Acquired with a Remidio FOP fundus camera:
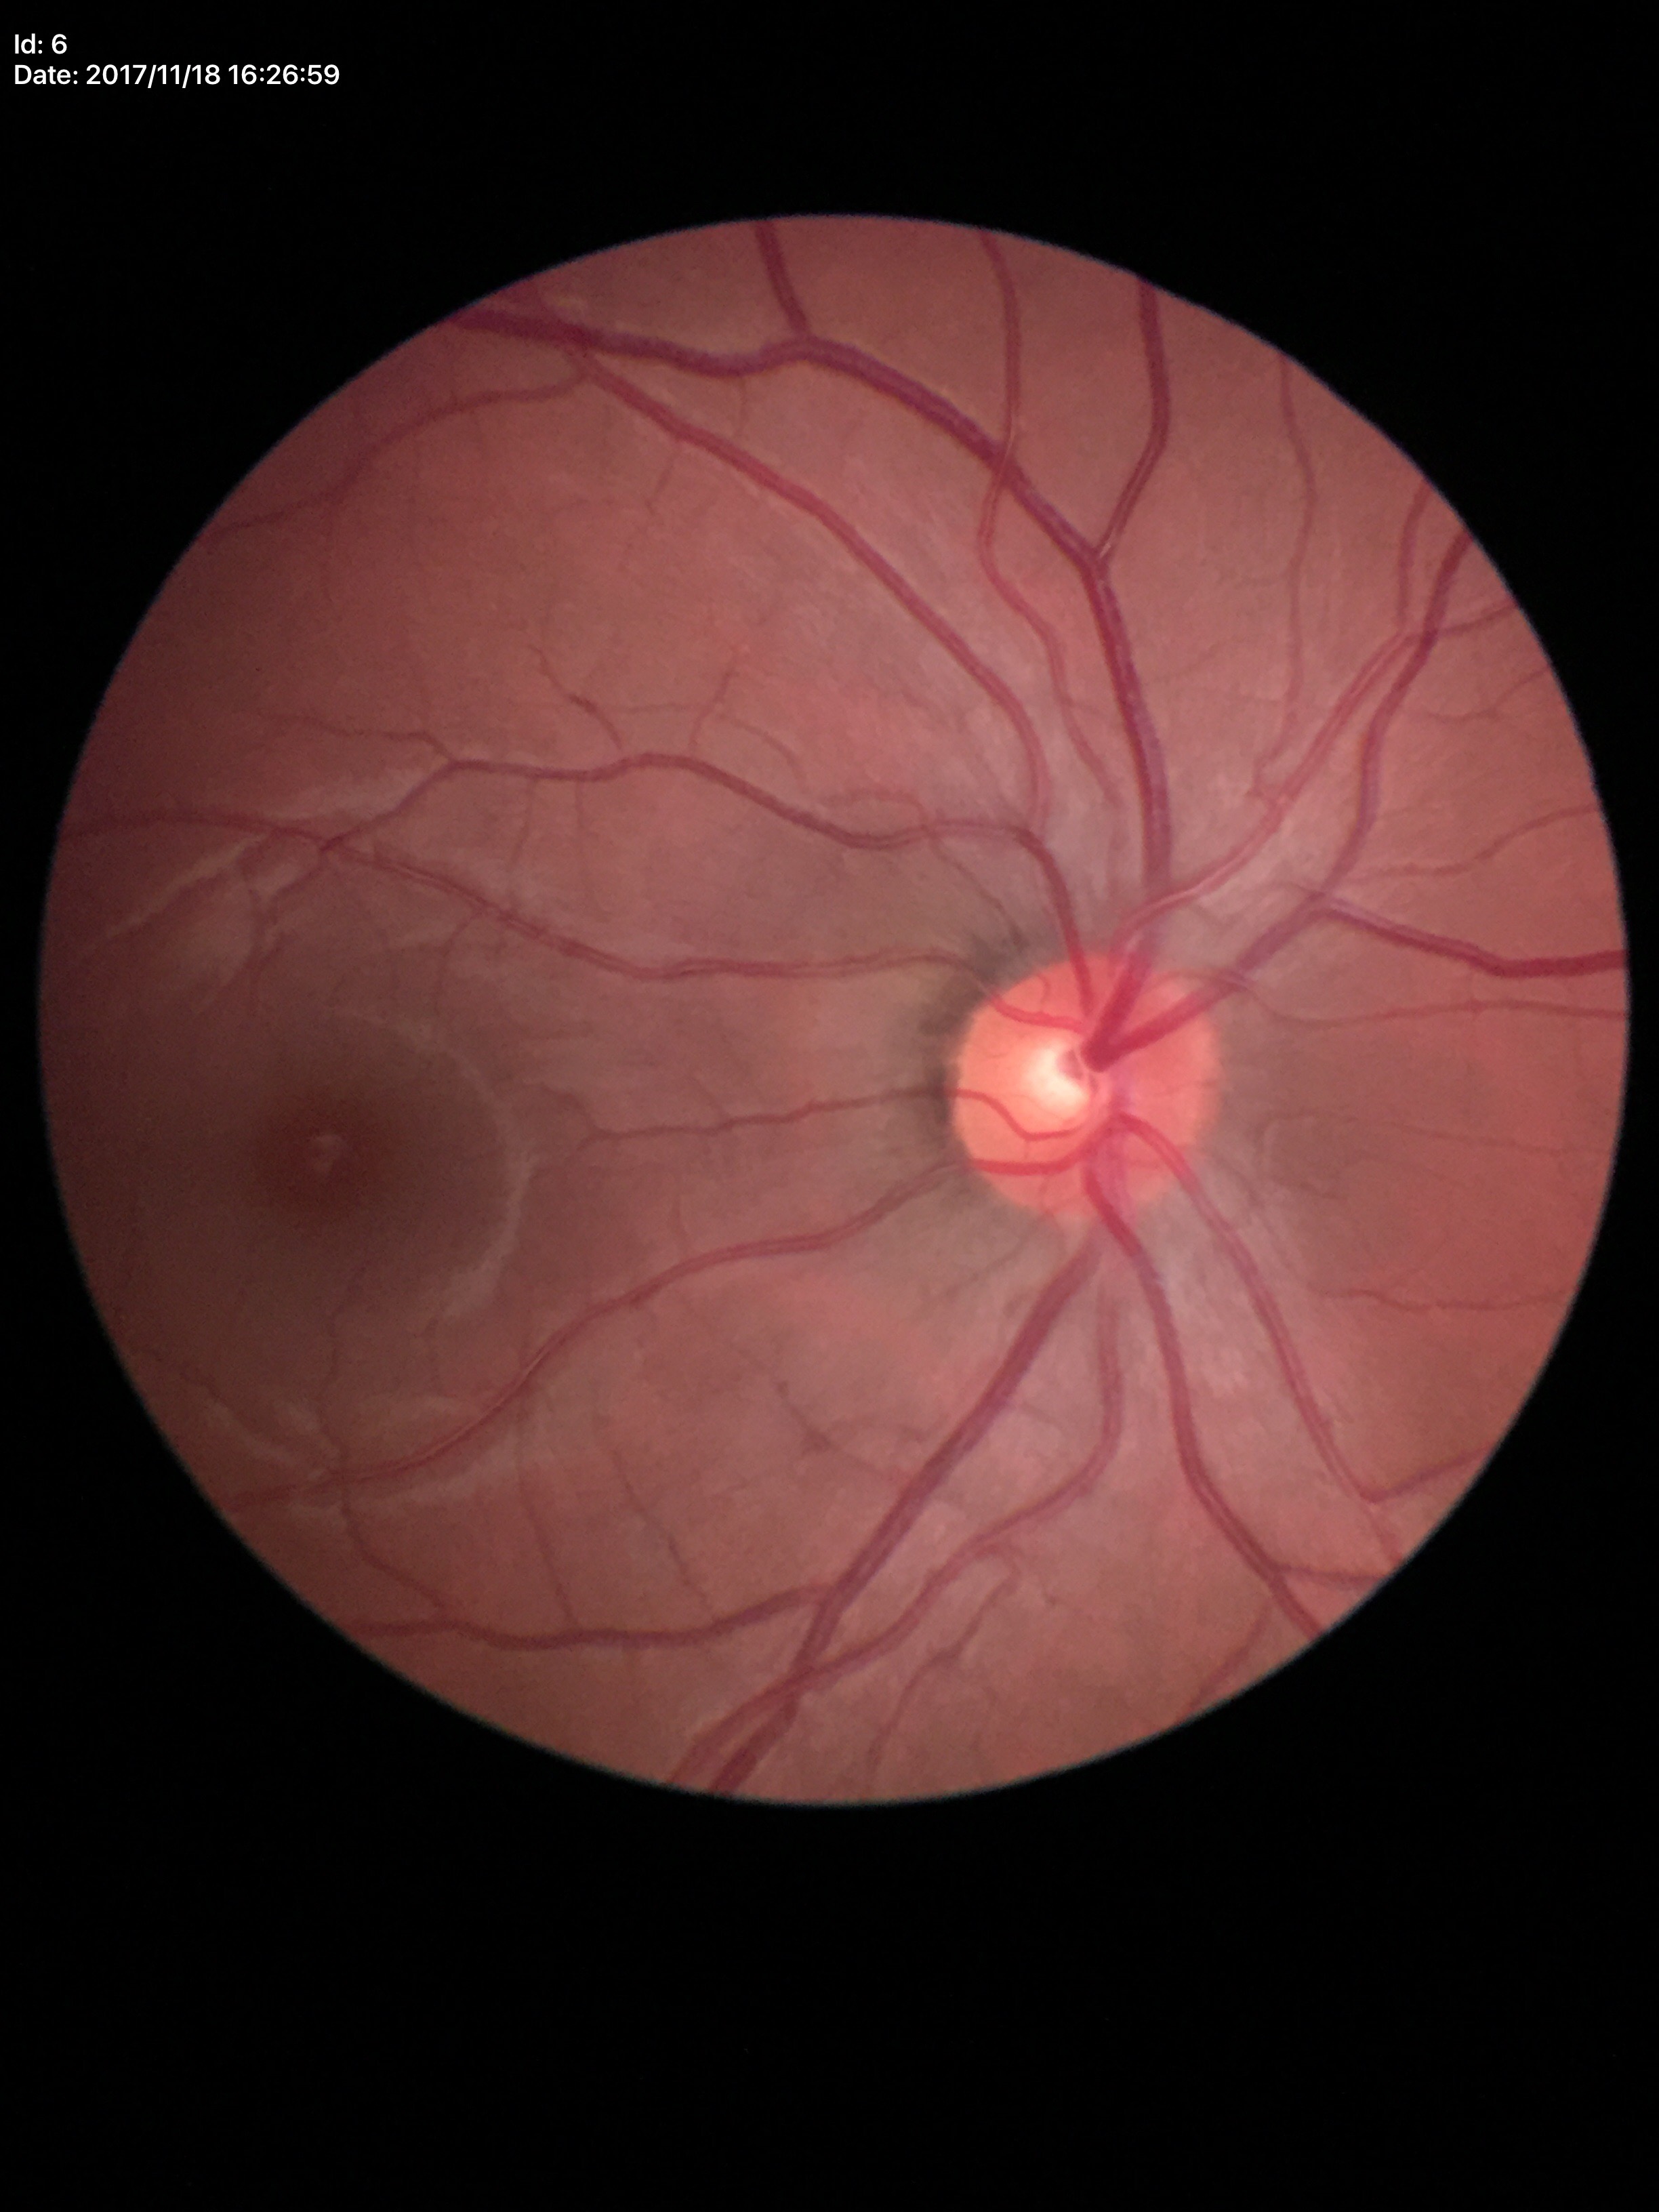

Glaucoma impression: negative (all 5 graders called normal); VCDR: 0.46; HCDR: 0.45